Diabetic retinopathy graded by the modified Davis classification; no pharmacologic dilation.
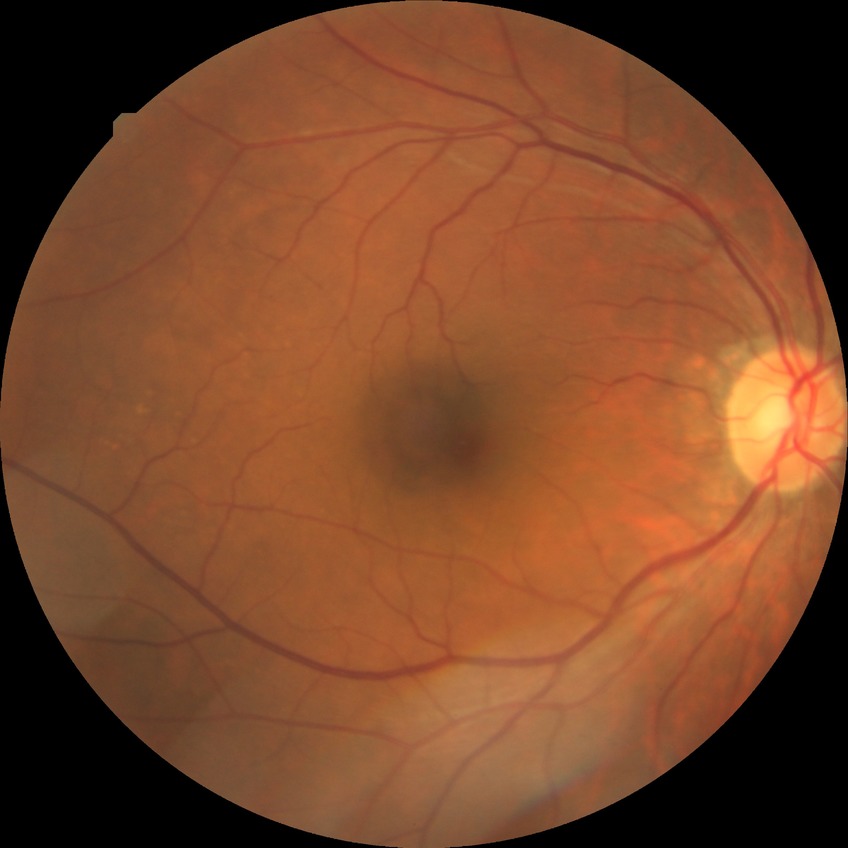
Davis grading is no diabetic retinopathy.